Wide-field fundus photograph from neonatal ROP screening; 1240x1240:
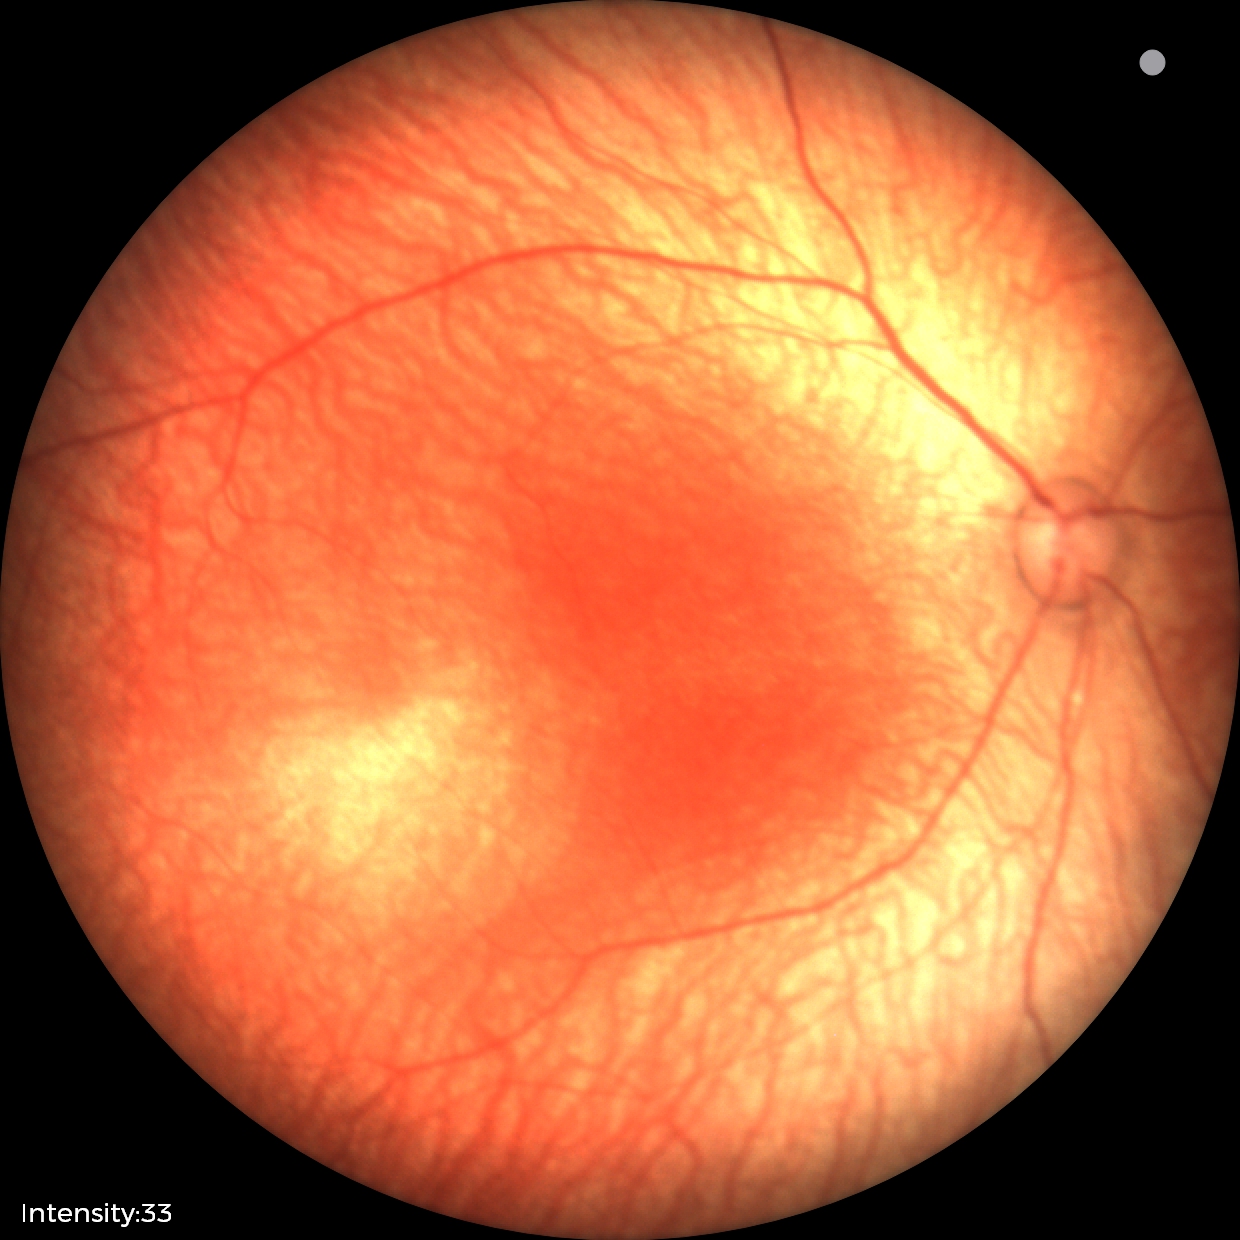

Normal screening examination.